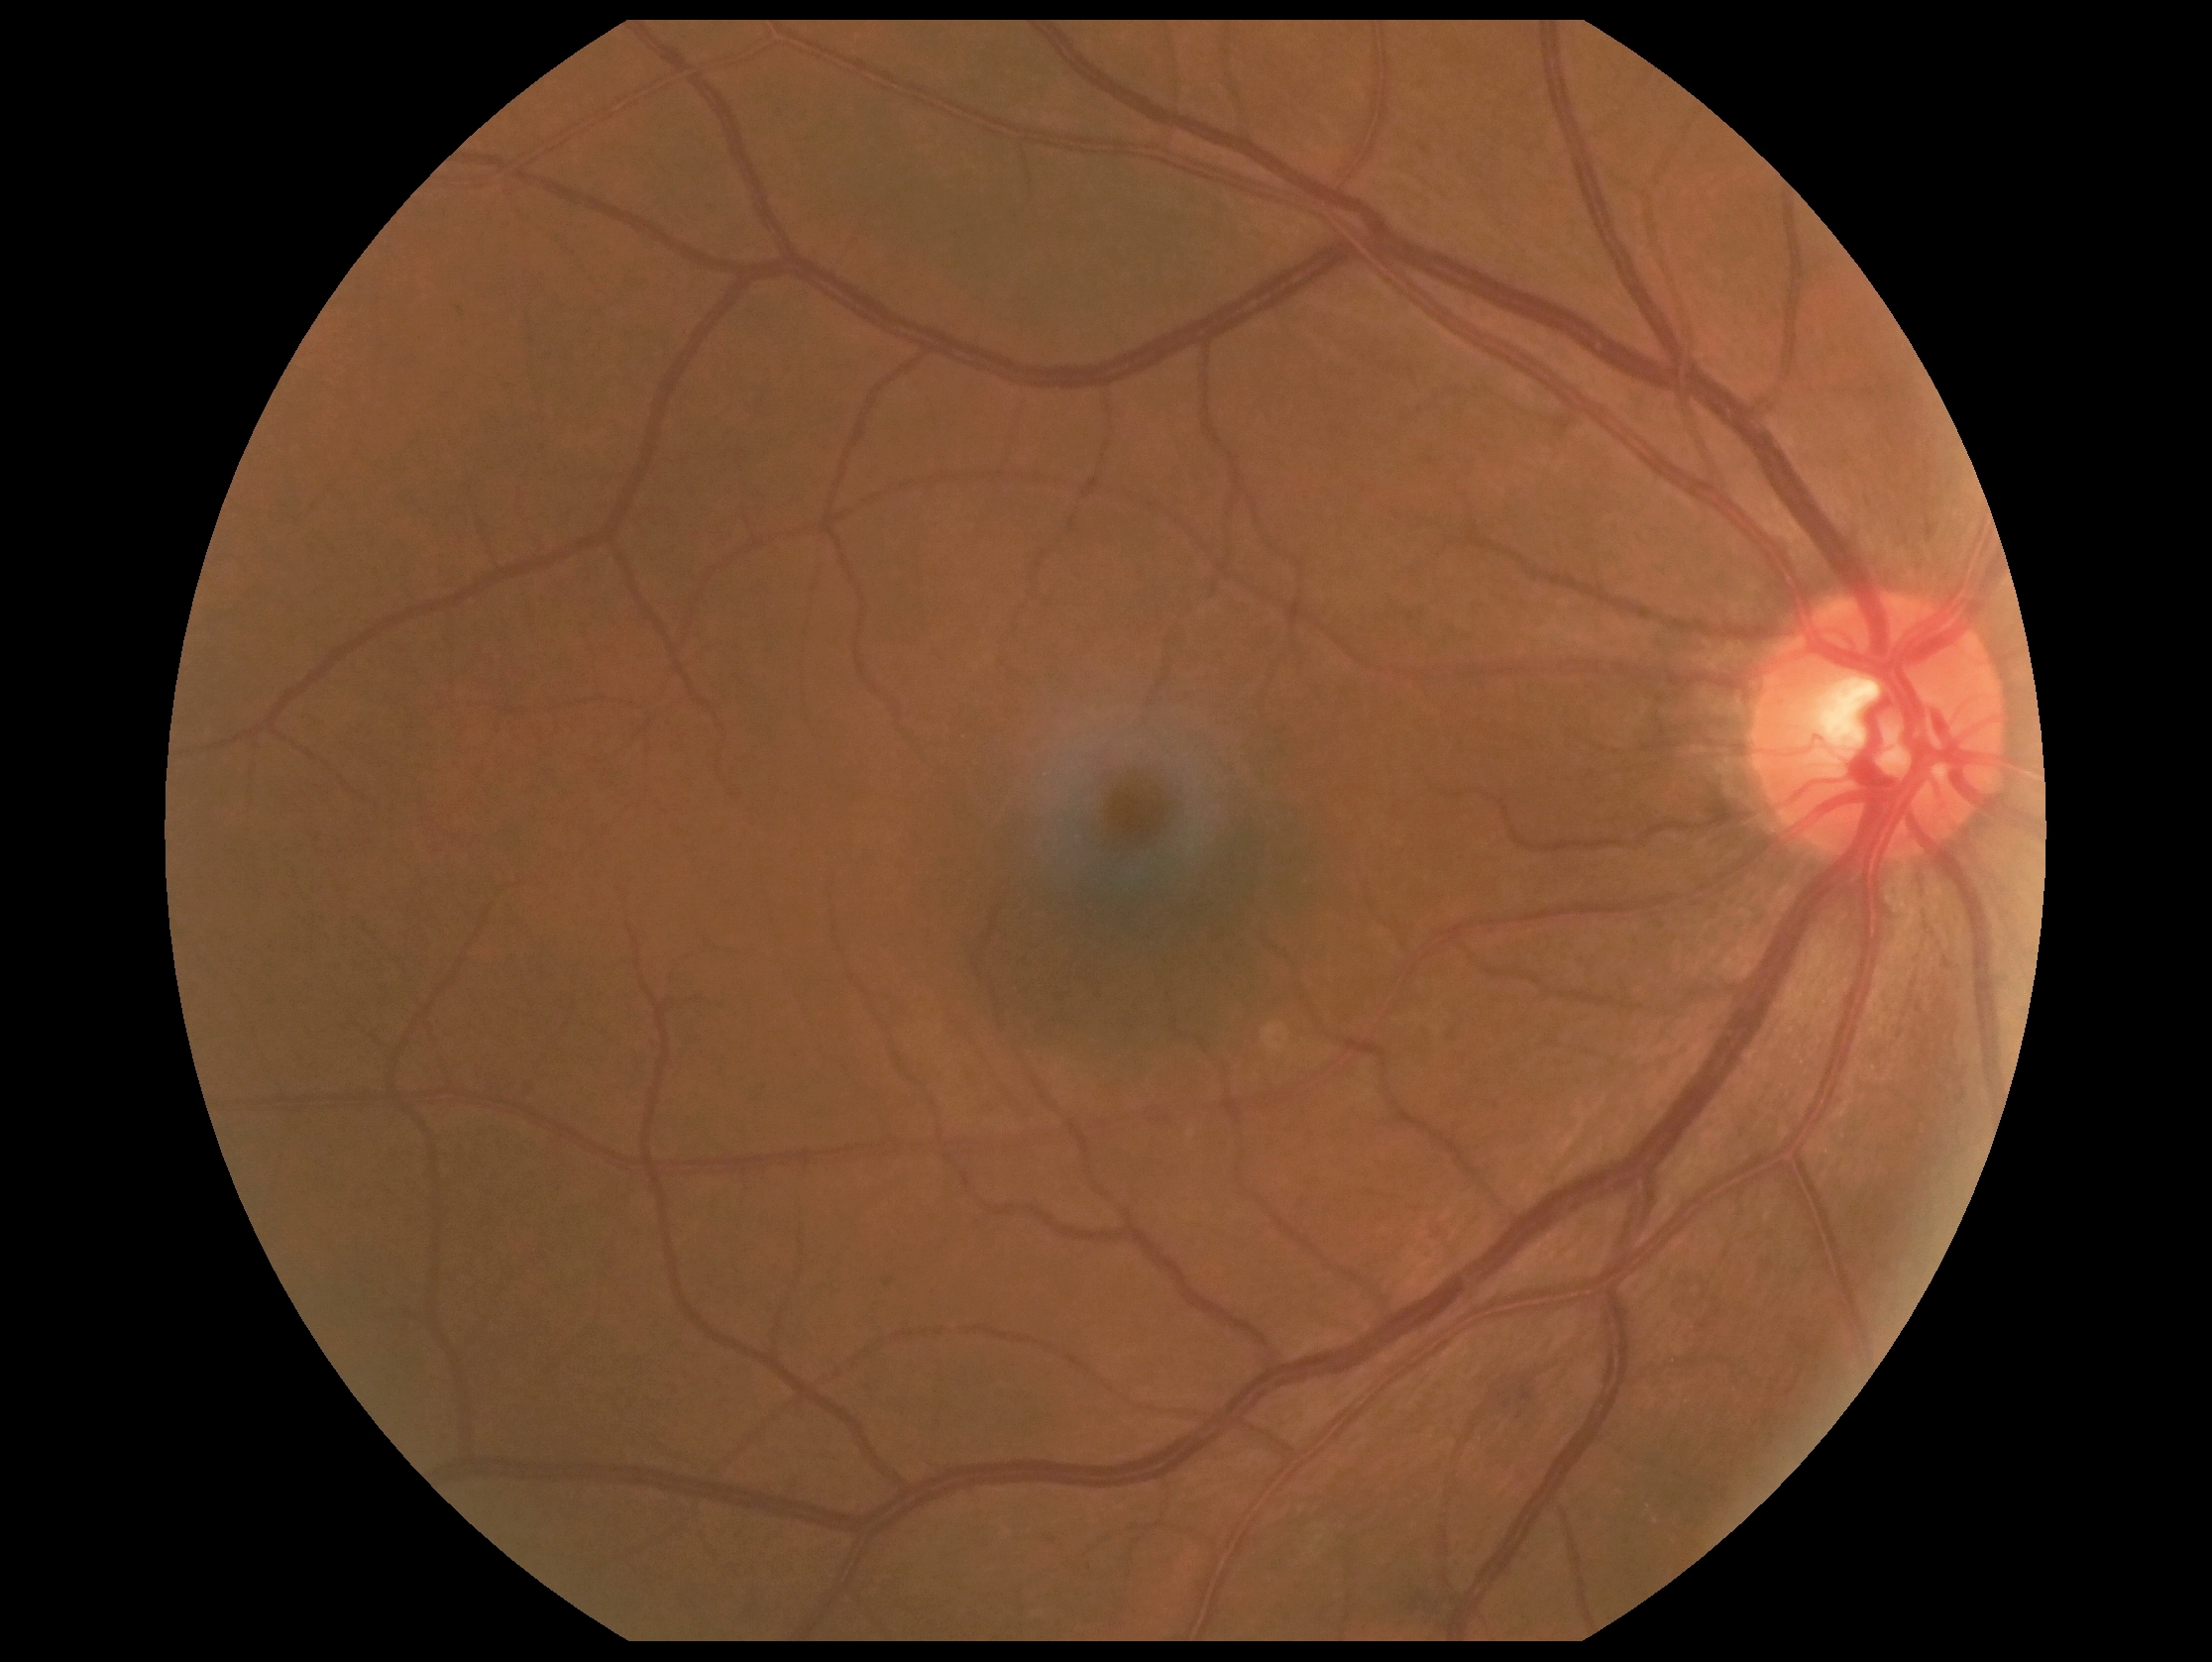 Retinopathy grade: 2/4.